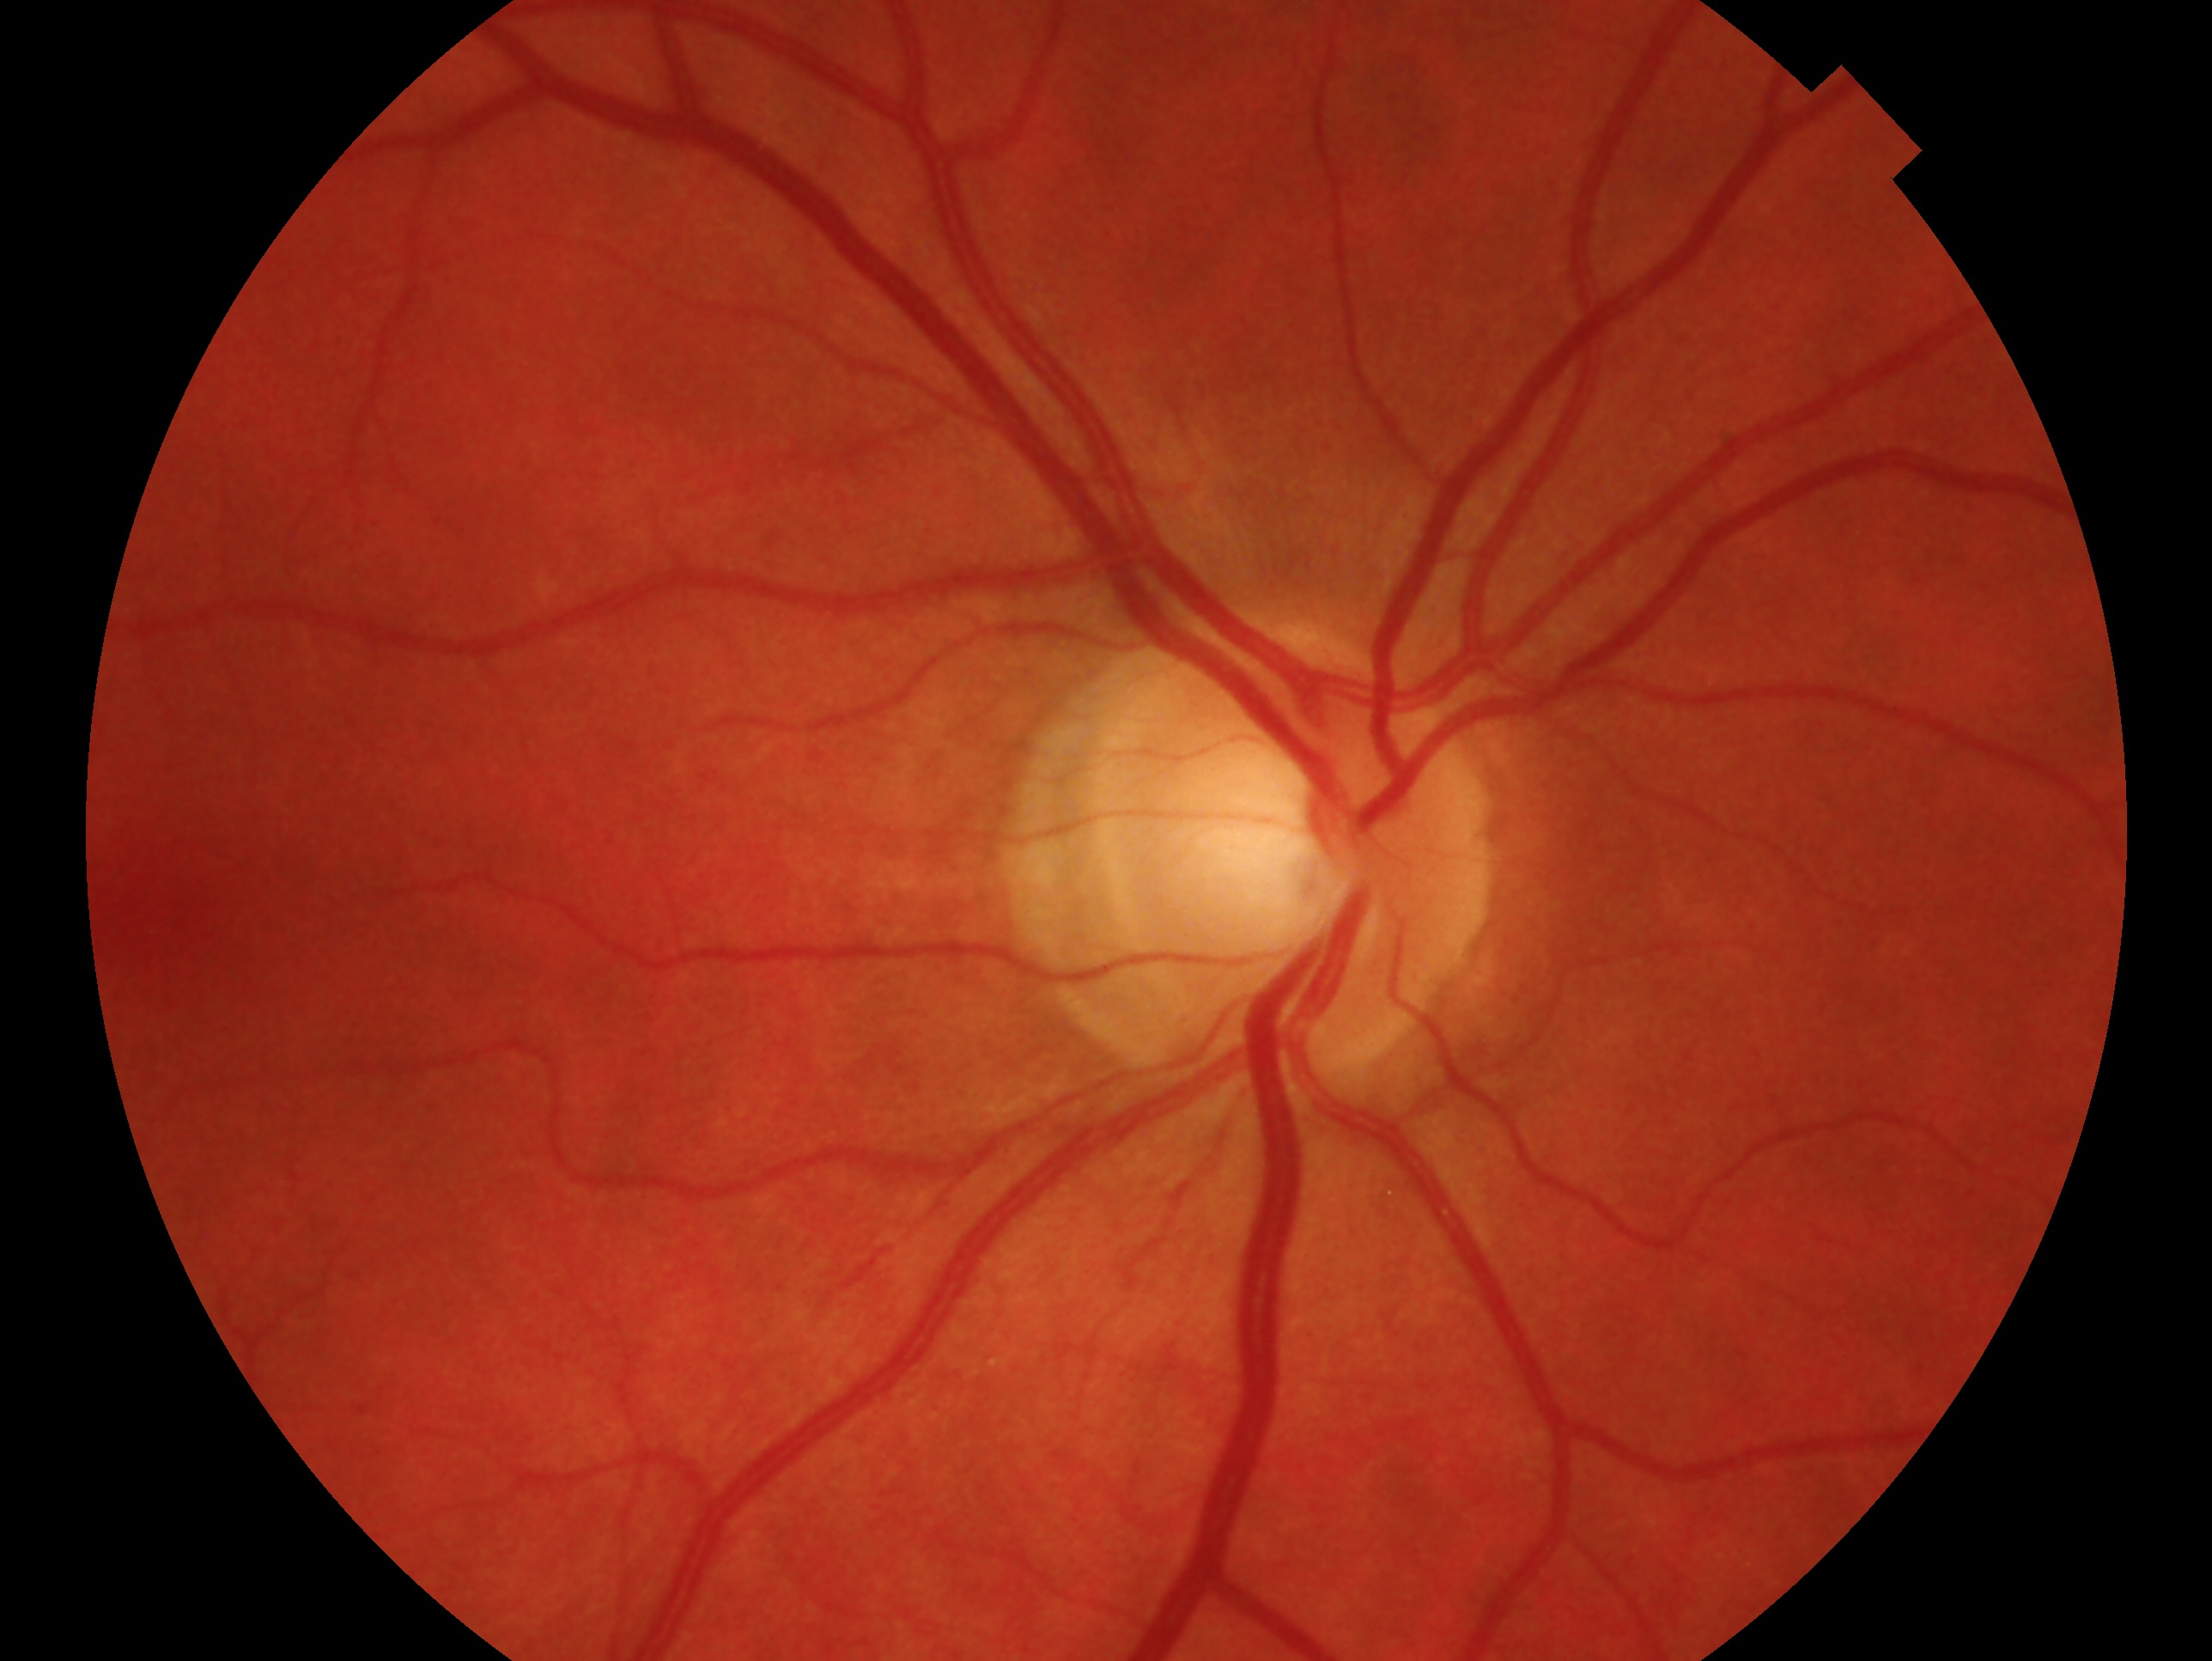
Assessment: no signs of glaucoma.
This is the right eye.